Wide-field fundus photograph of an infant: 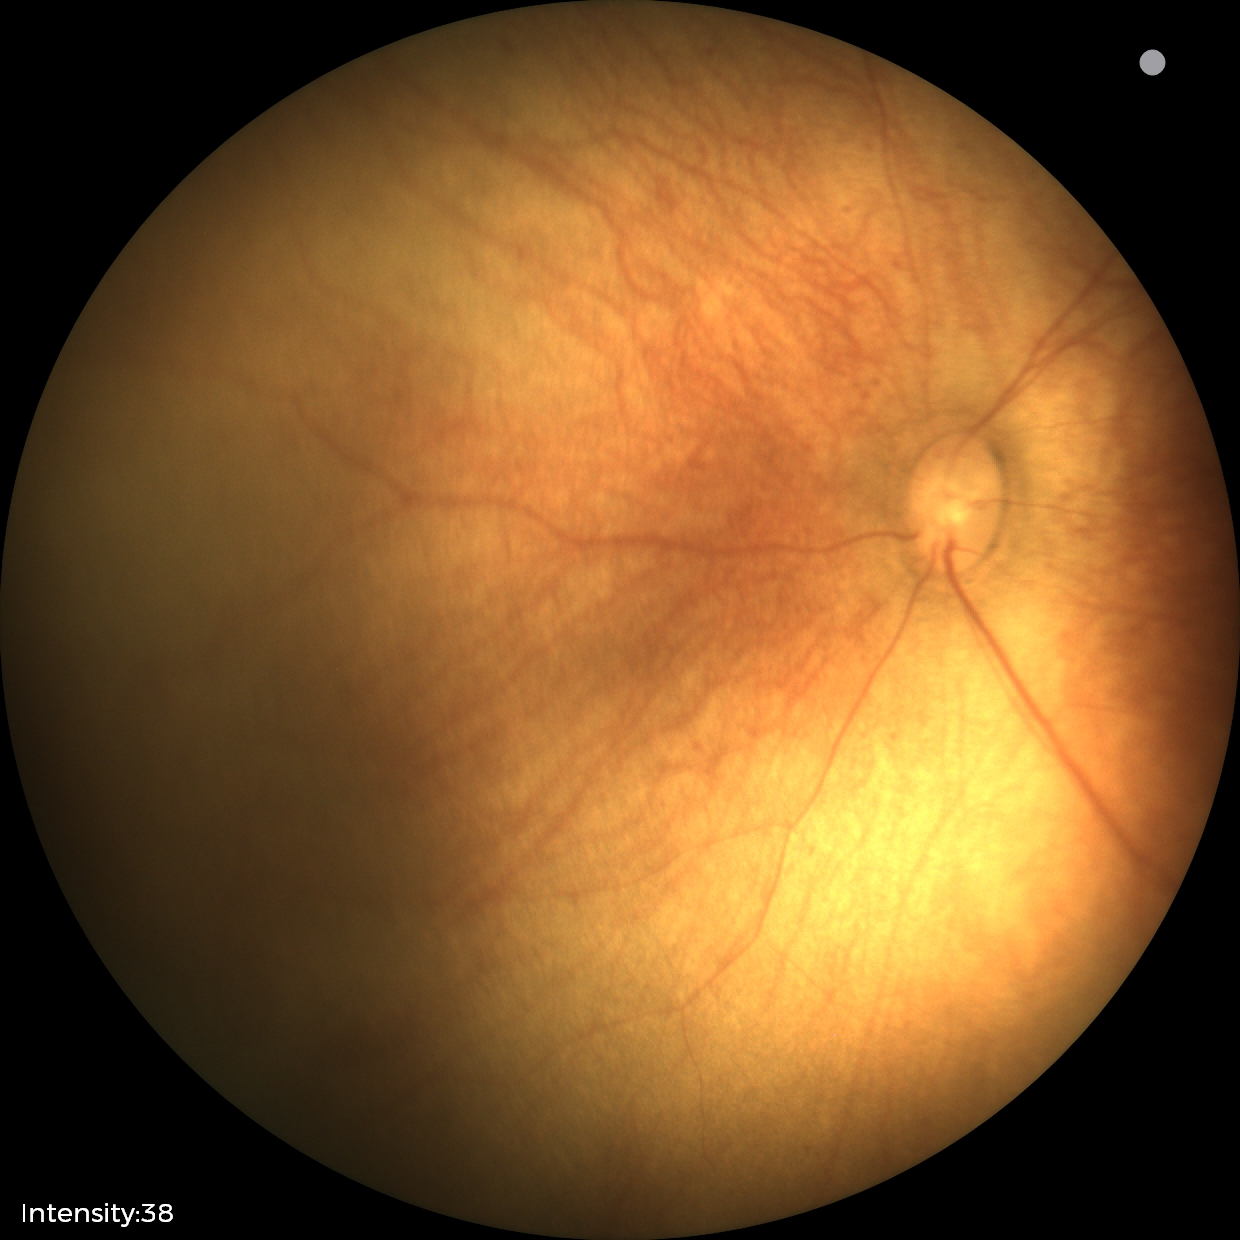 Impression = physiological appearance.